Image size 2048x1536; color fundus photograph: 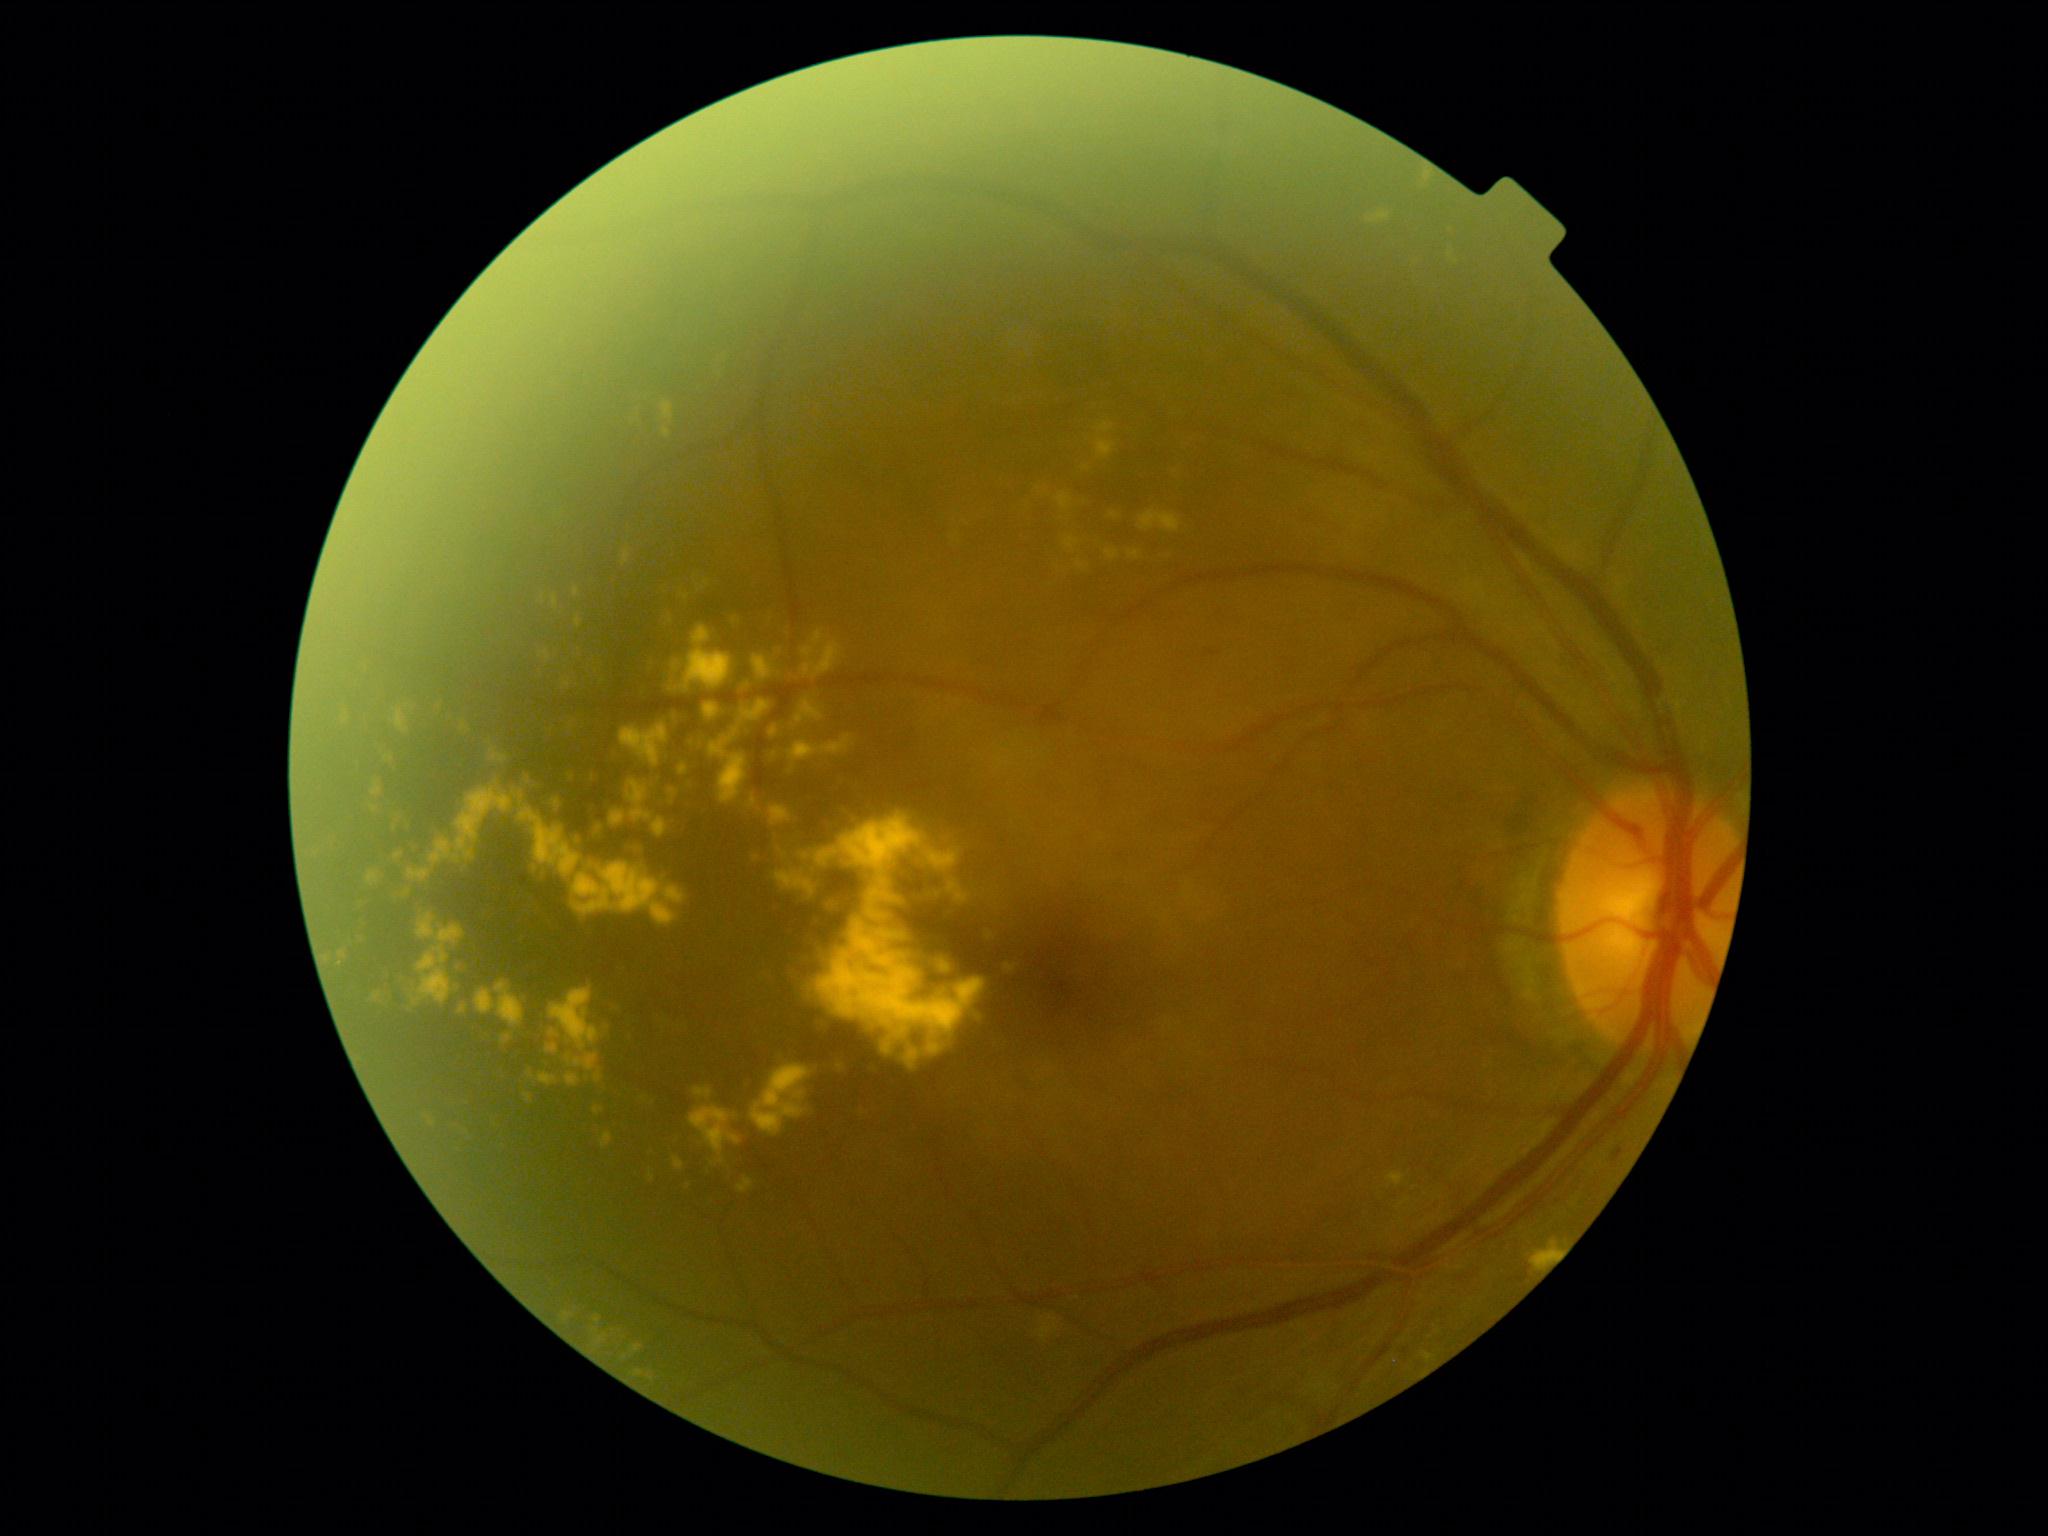 DR severity = moderate NPDR (grade 2) | DR class = non-proliferative diabetic retinopathy.